Topcon TRC-NW400 — 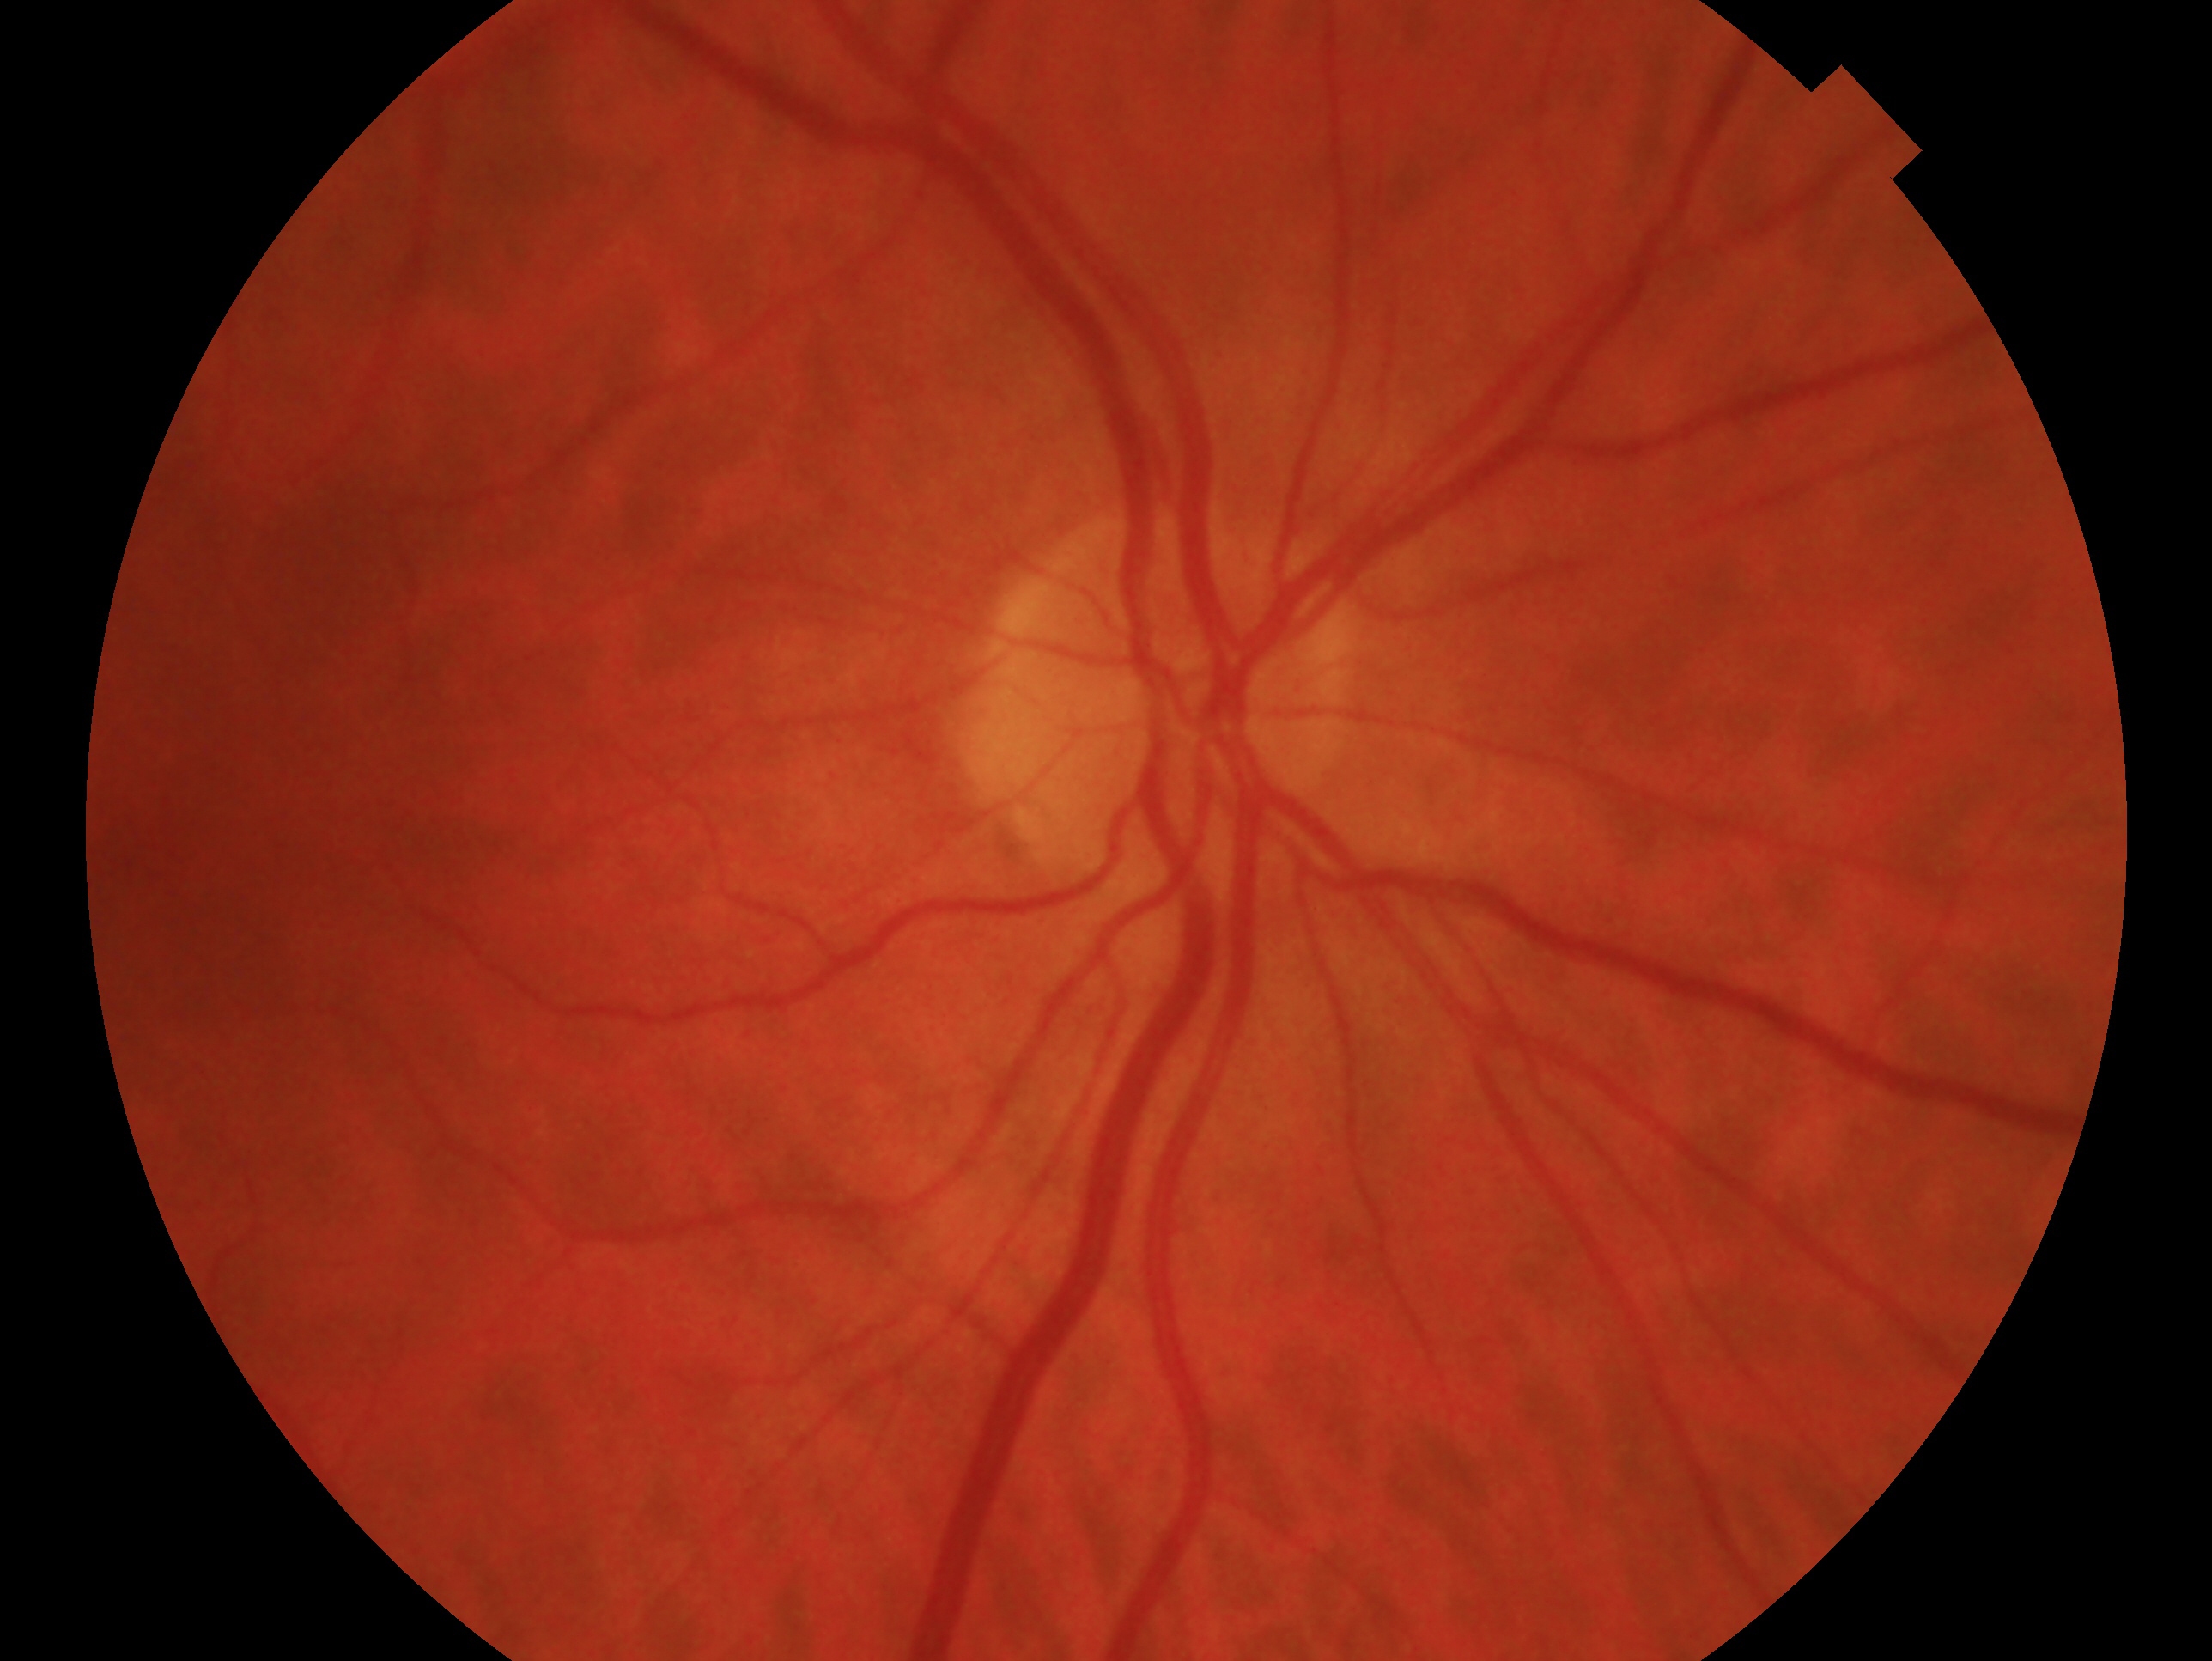 eye: OD | glaucoma status: negative for glaucoma.